45° field of view, color fundus image: 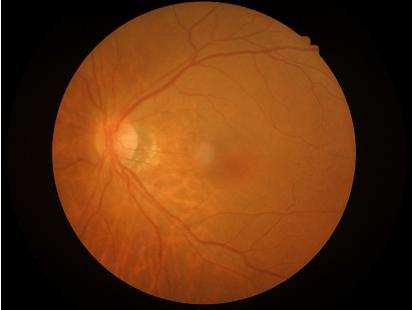
Vessels and details are readily distinguishable. Acceptable image quality.